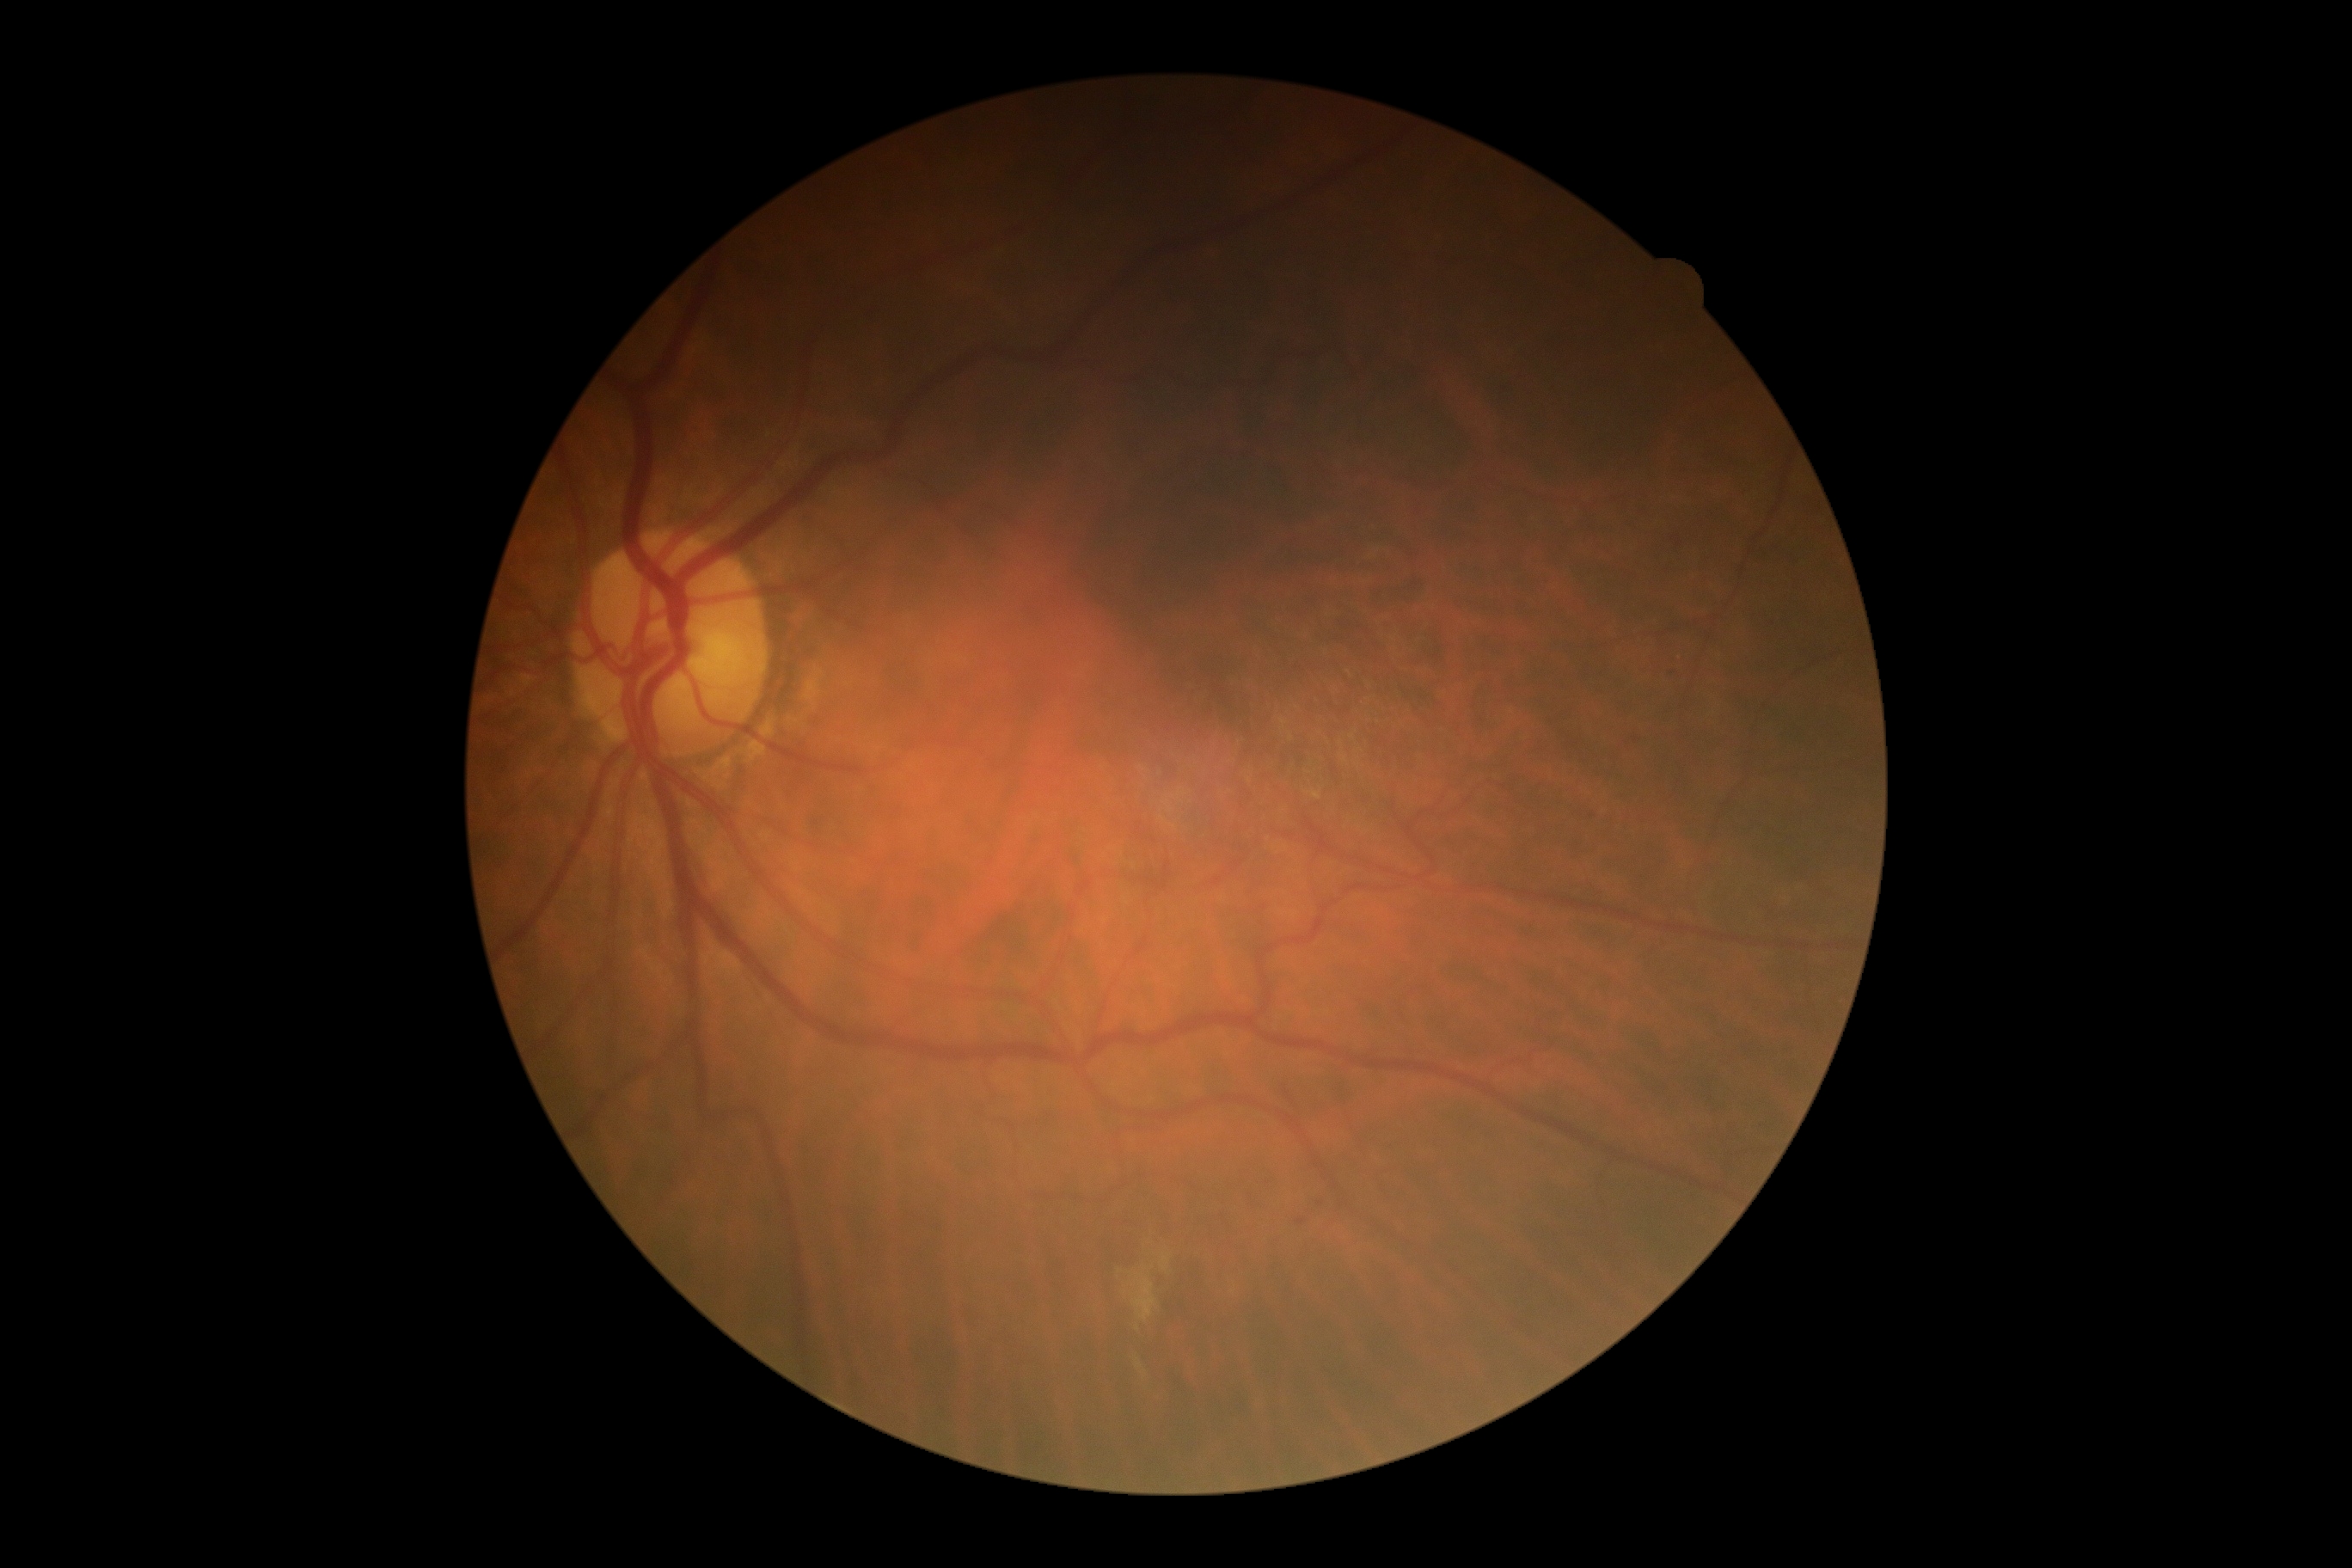
DR class = non-proliferative diabetic retinopathy, diabetic retinopathy (DR) = 2/4.